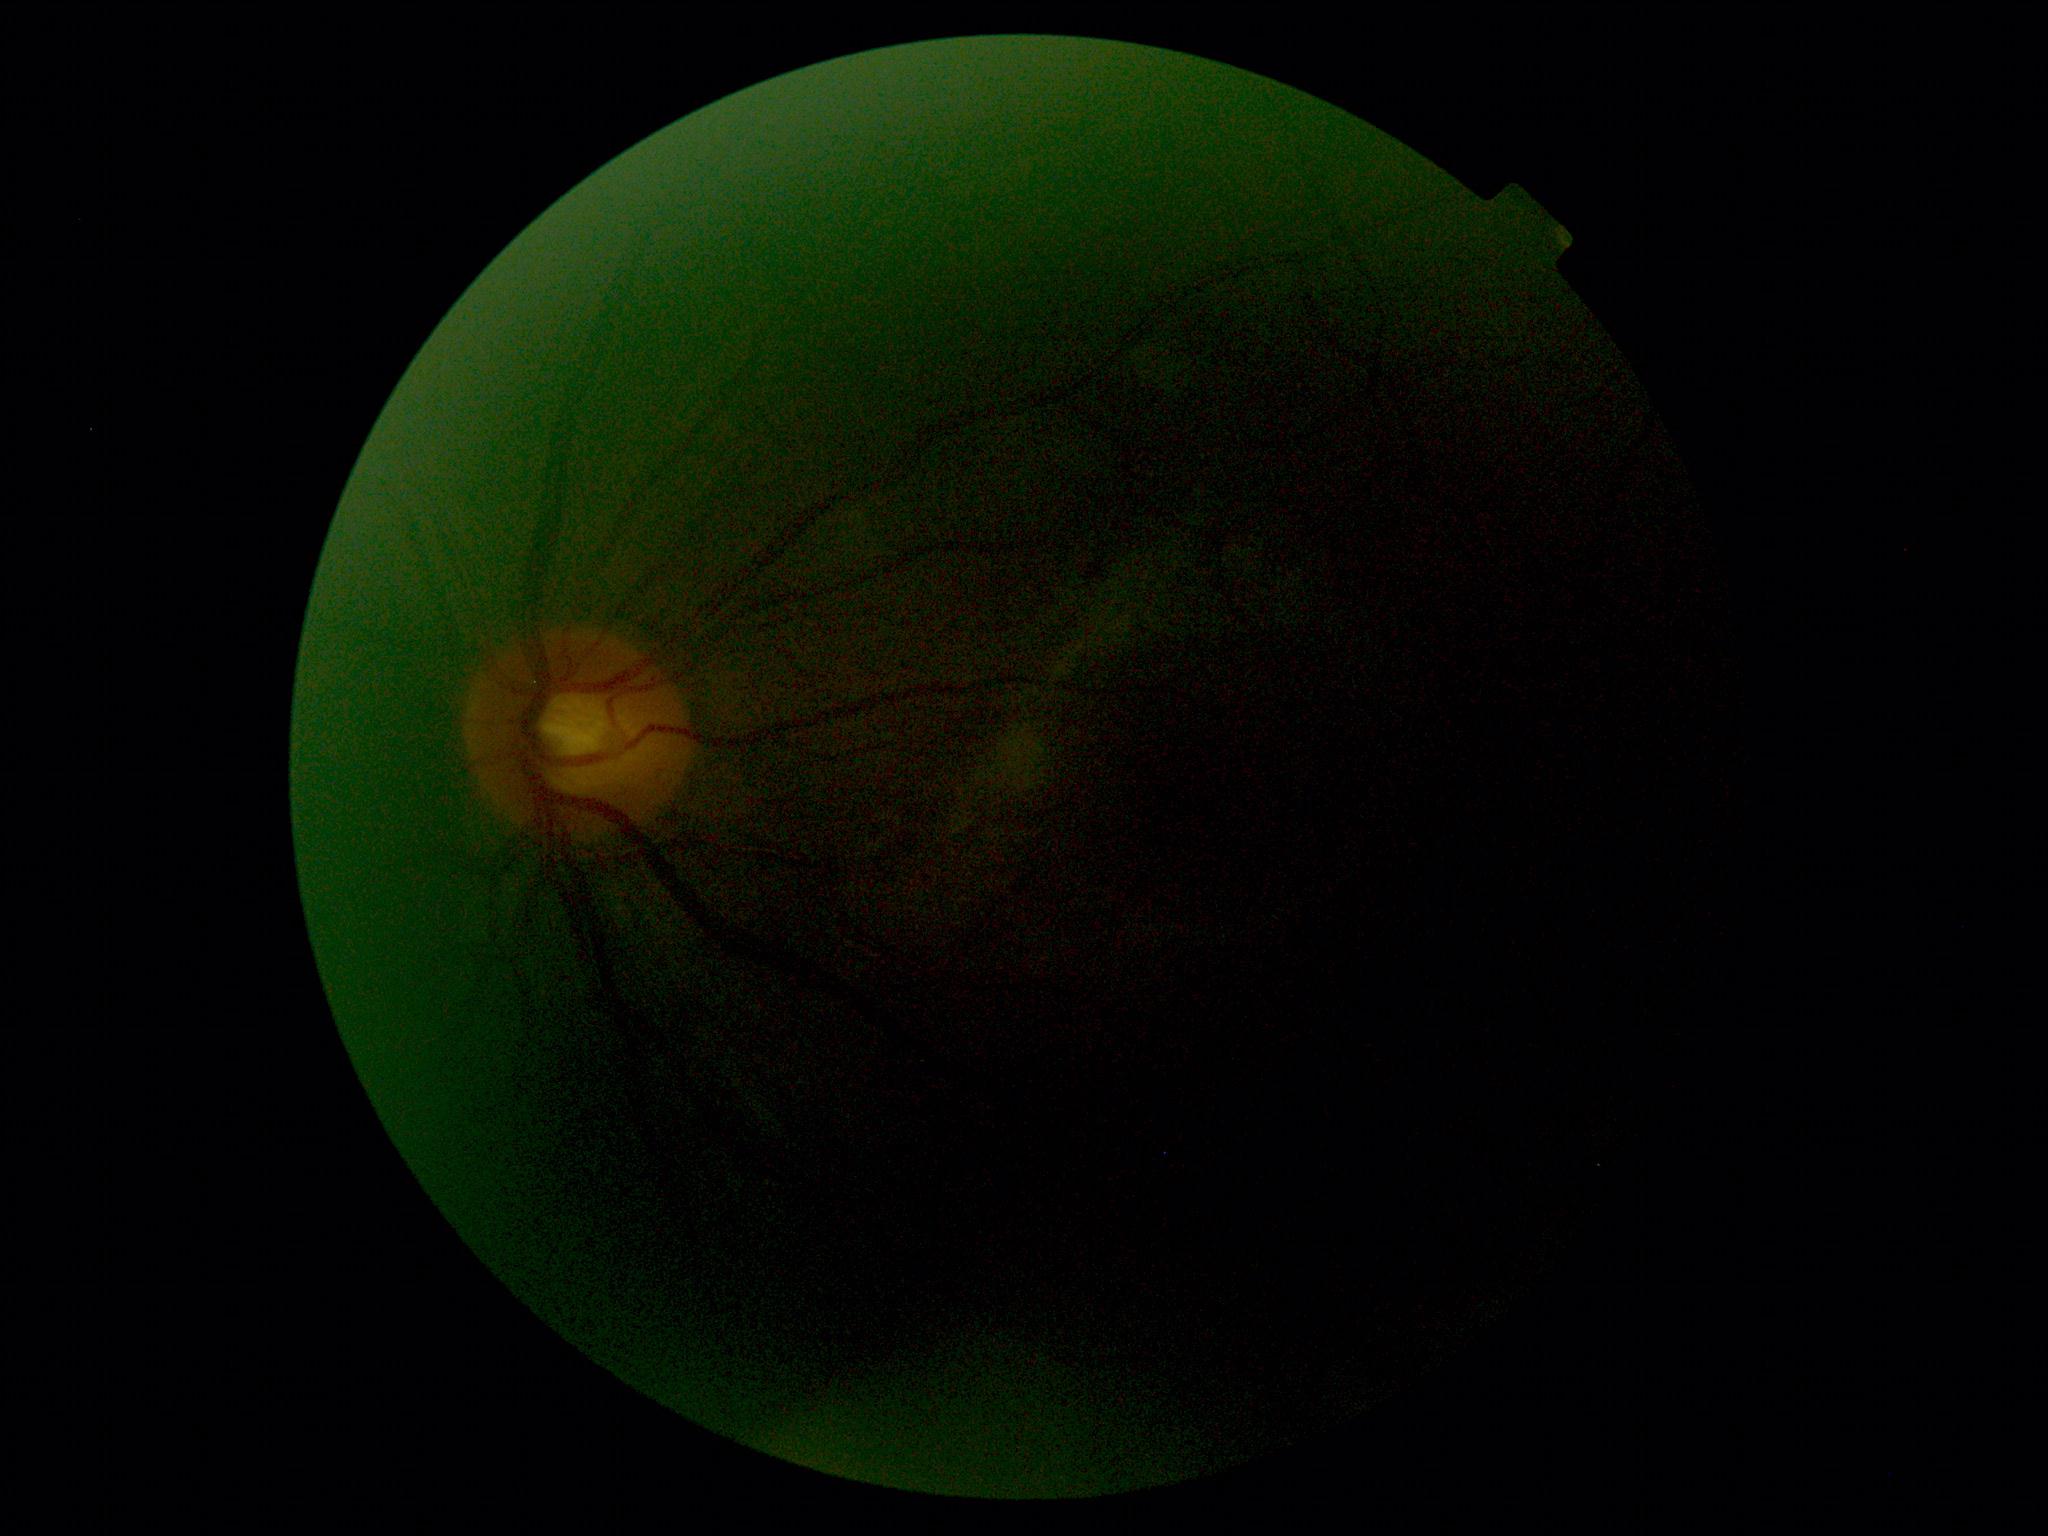 diabetic retinopathy: ungradable; image quality: insufficient.